640x480; infant wide-field retinal image:
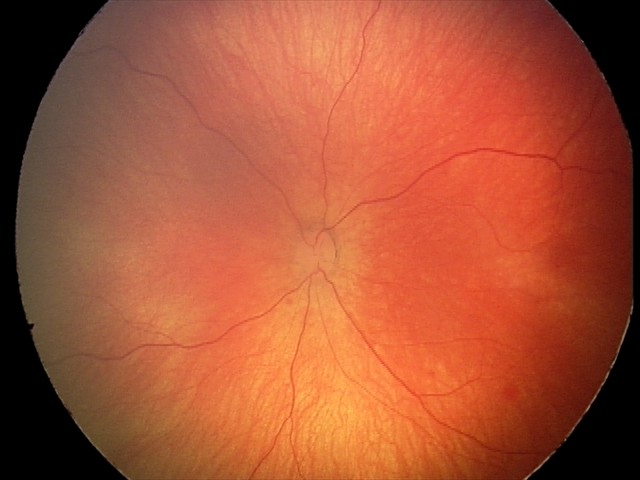

Screening series with retinal hemorrhages.